Image size 1440x1080 · wide-field contact fundus photograph of an infant — 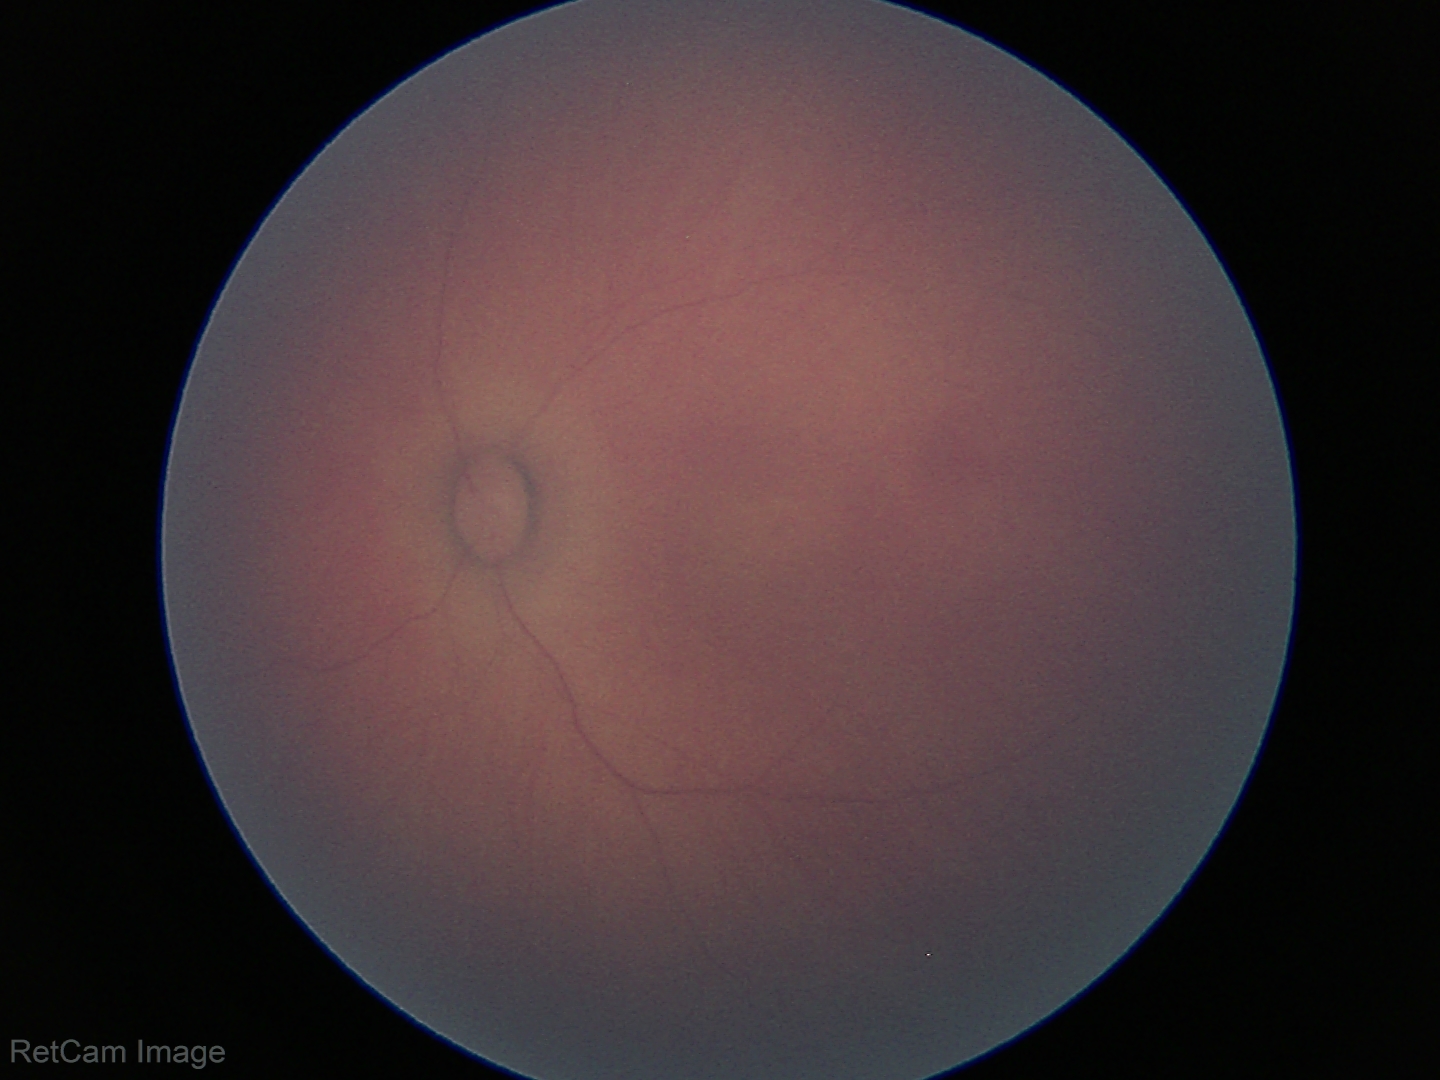 Screening examination with no abnormal retinal findings.